Acquired on the Phoenix ICON. Phoenix ICON wide-field infant fundus image. 1240 by 1240 pixels:
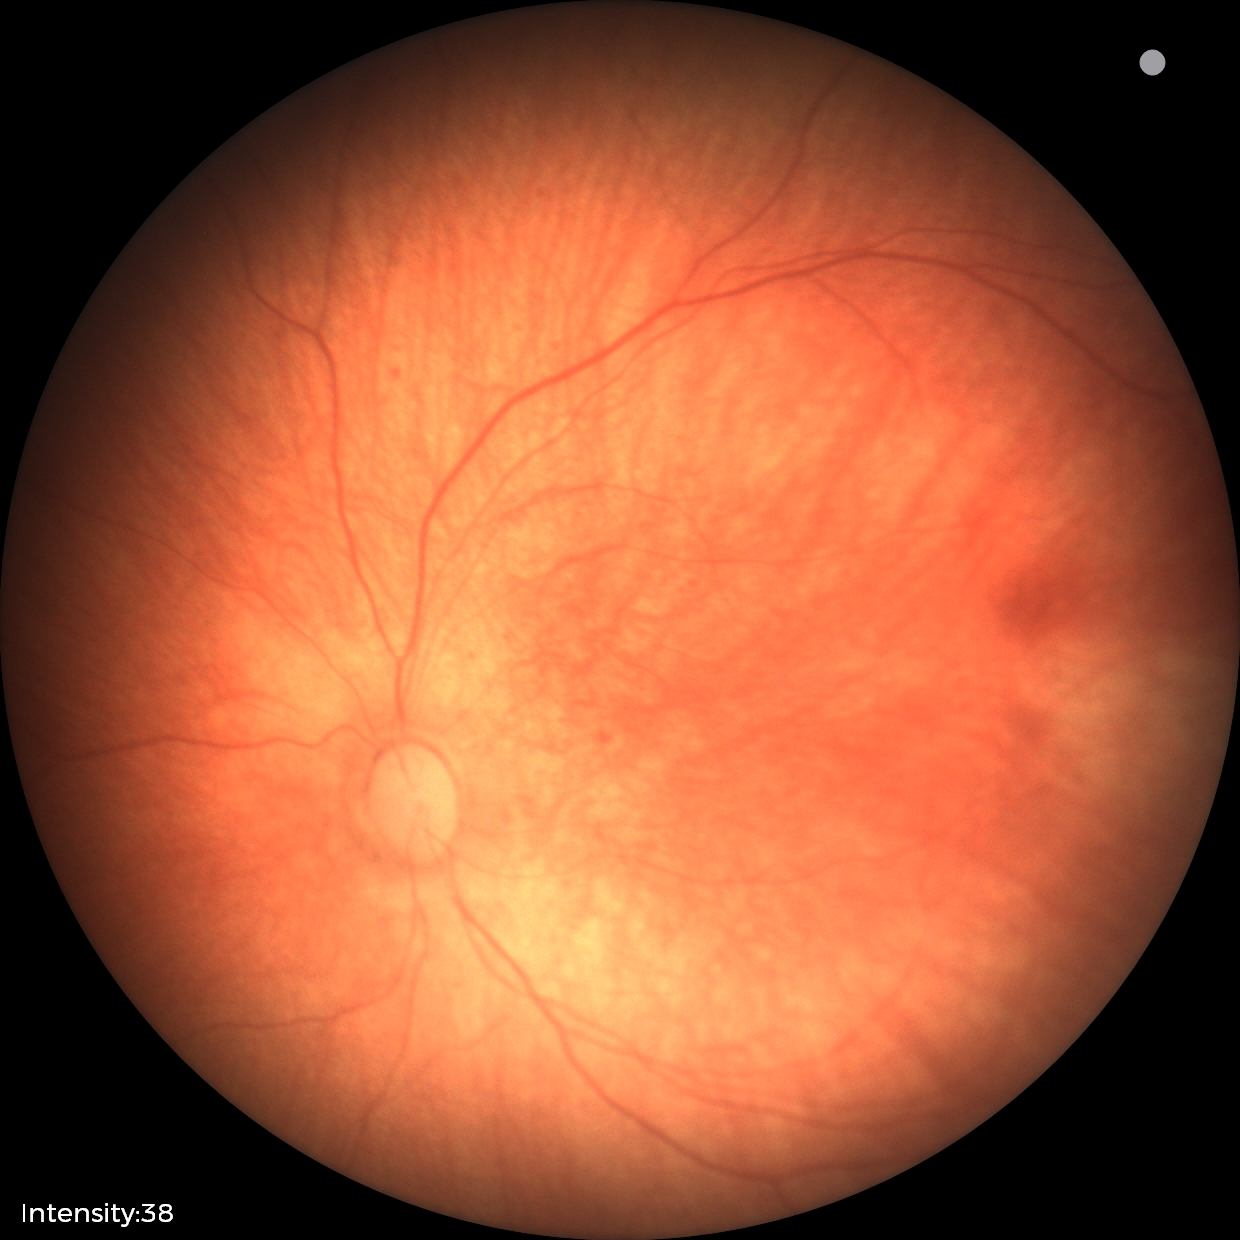
Examination with physiological retinal findings.